Camera: NIDEK AFC-230, modified Davis grading:
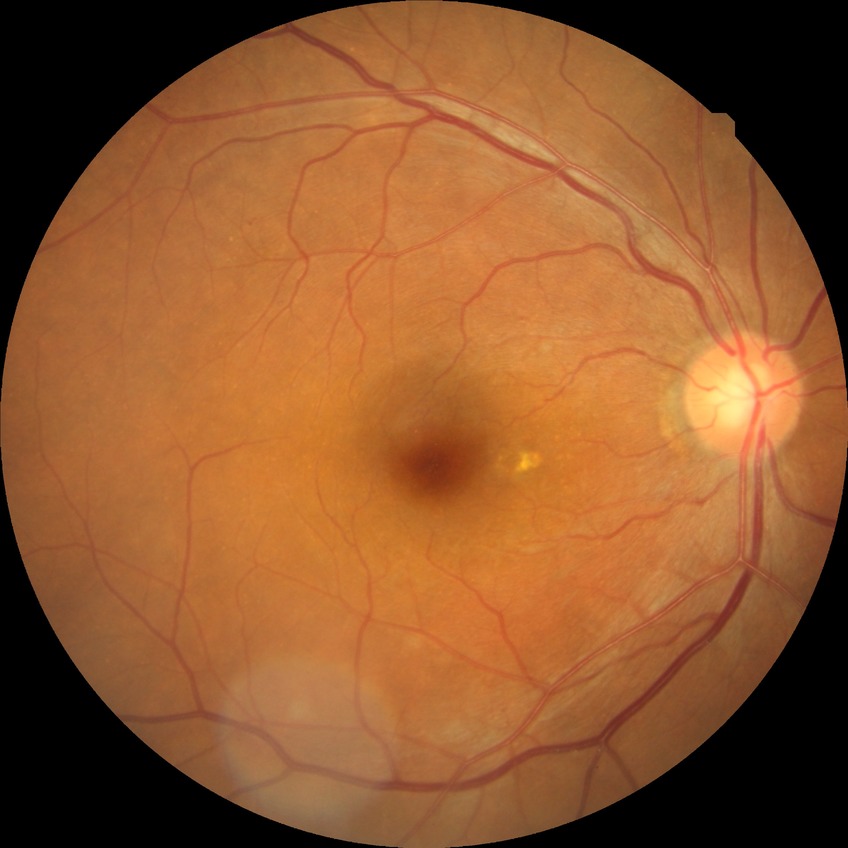
Davis stage is SDR.